Color fundus photograph.
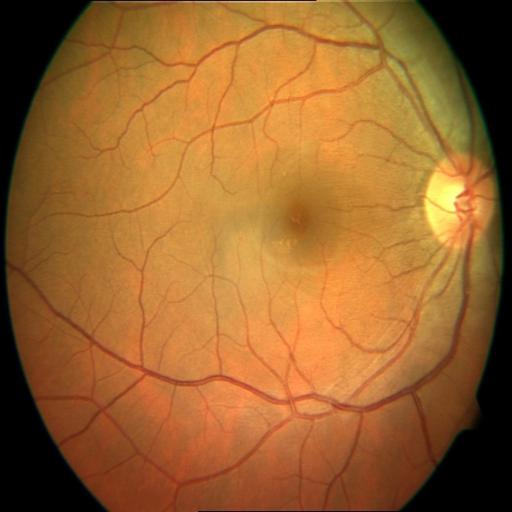

Impression:
- central serous retinopathy (CSR)